Central posterior field, pupil-dilated, captured on a Topcon TRC-50DX fundus camera
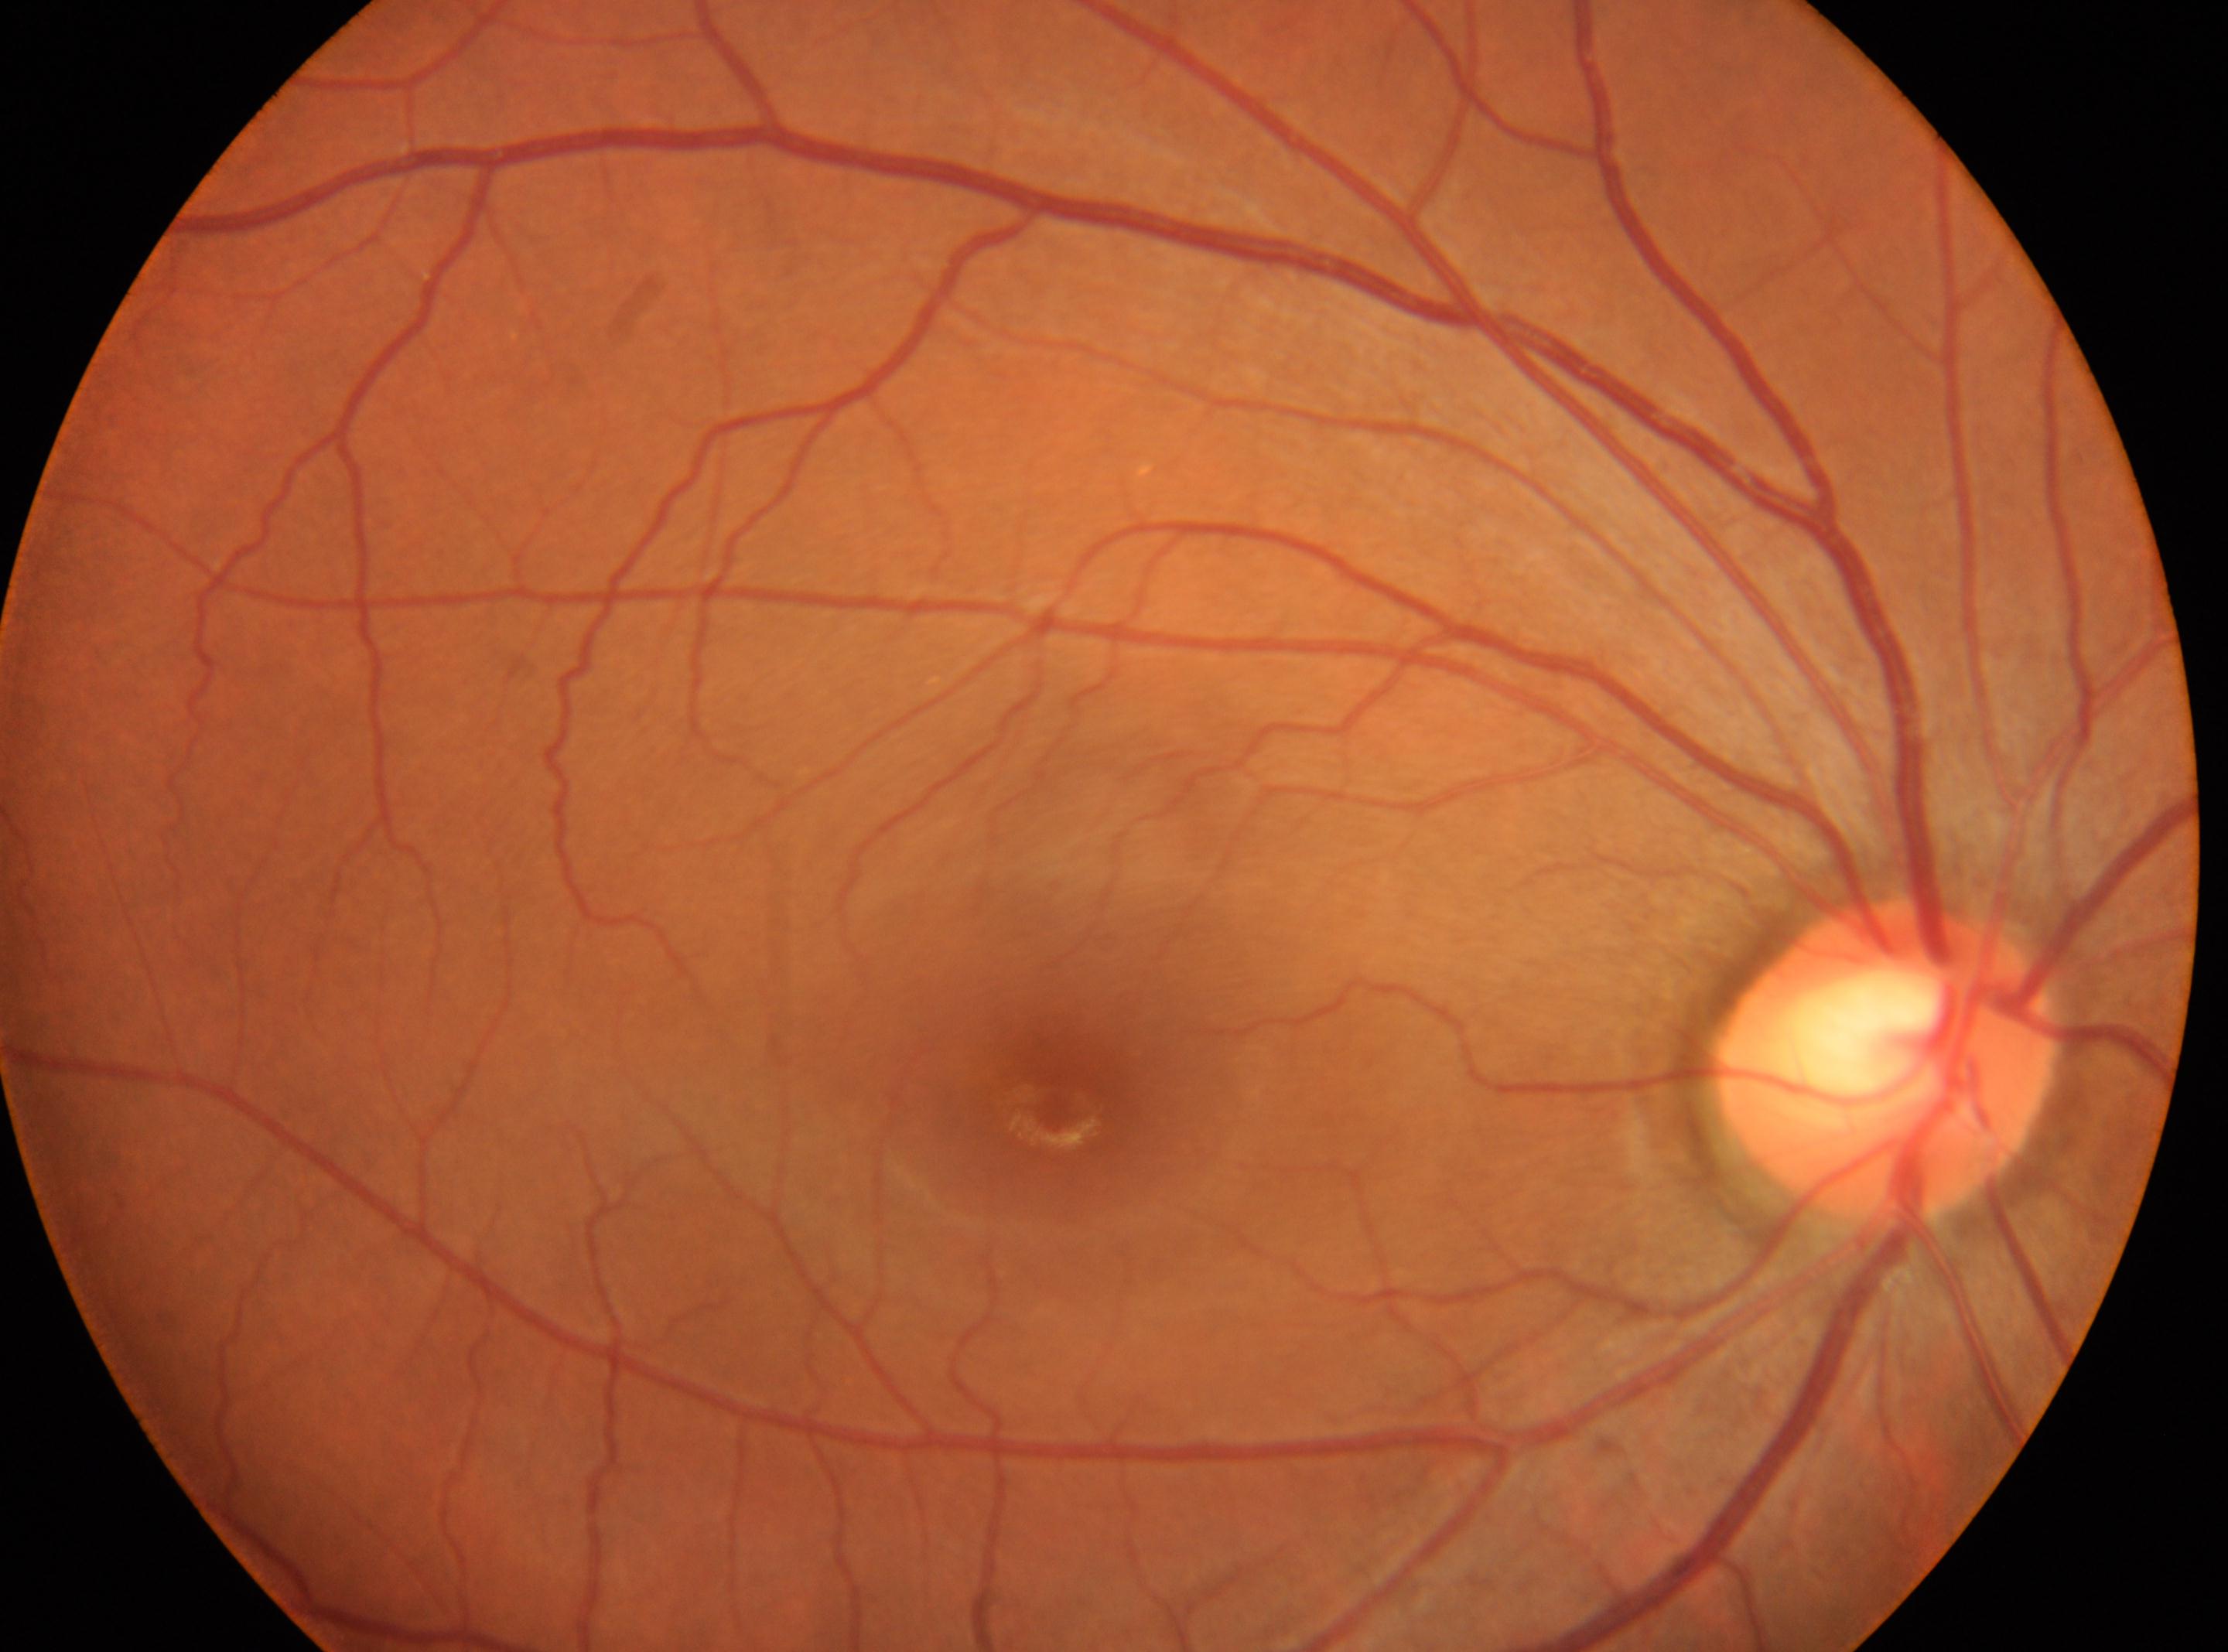

Imaged eye: OD. Optic disk: 1885, 1063. The fovea centralis is at 1057, 1100. Diabetic retinopathy (DR) is 0.